Modified Davis classification — 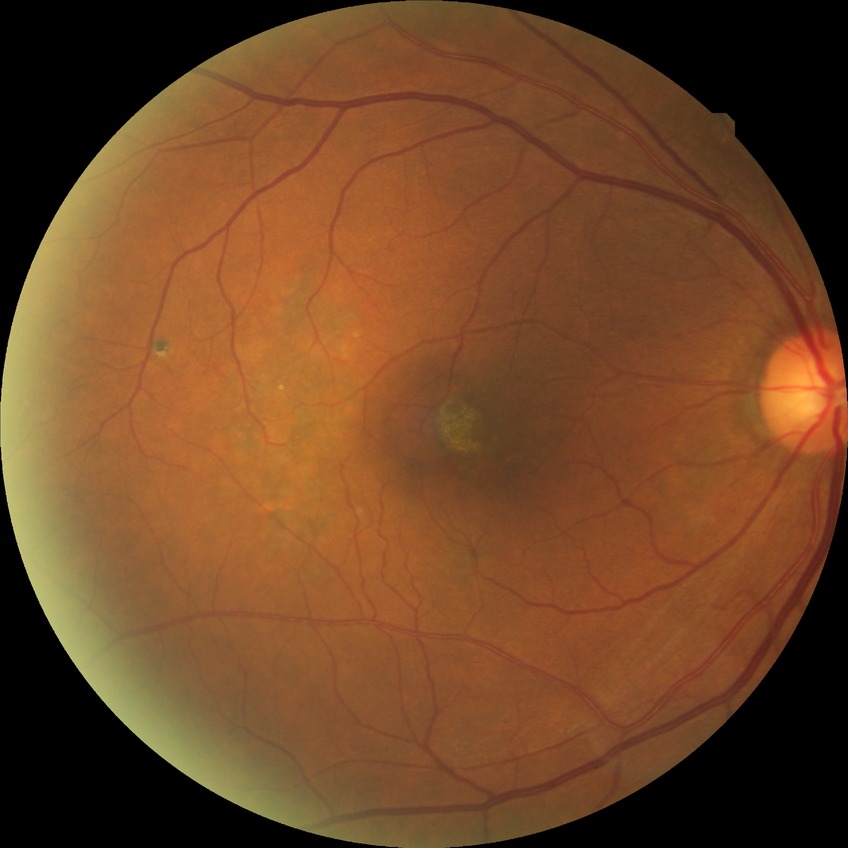 Diabetic retinopathy (DR) is no diabetic retinopathy (NDR).